RetCam wide-field infant fundus image; Clarity RetCam 3, 130° FOV.
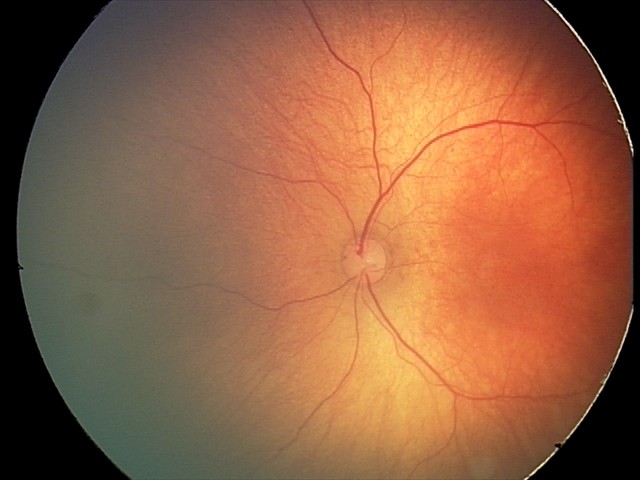 Screening diagnosis: physiological finding.